Fundus photo. 45° field of view: 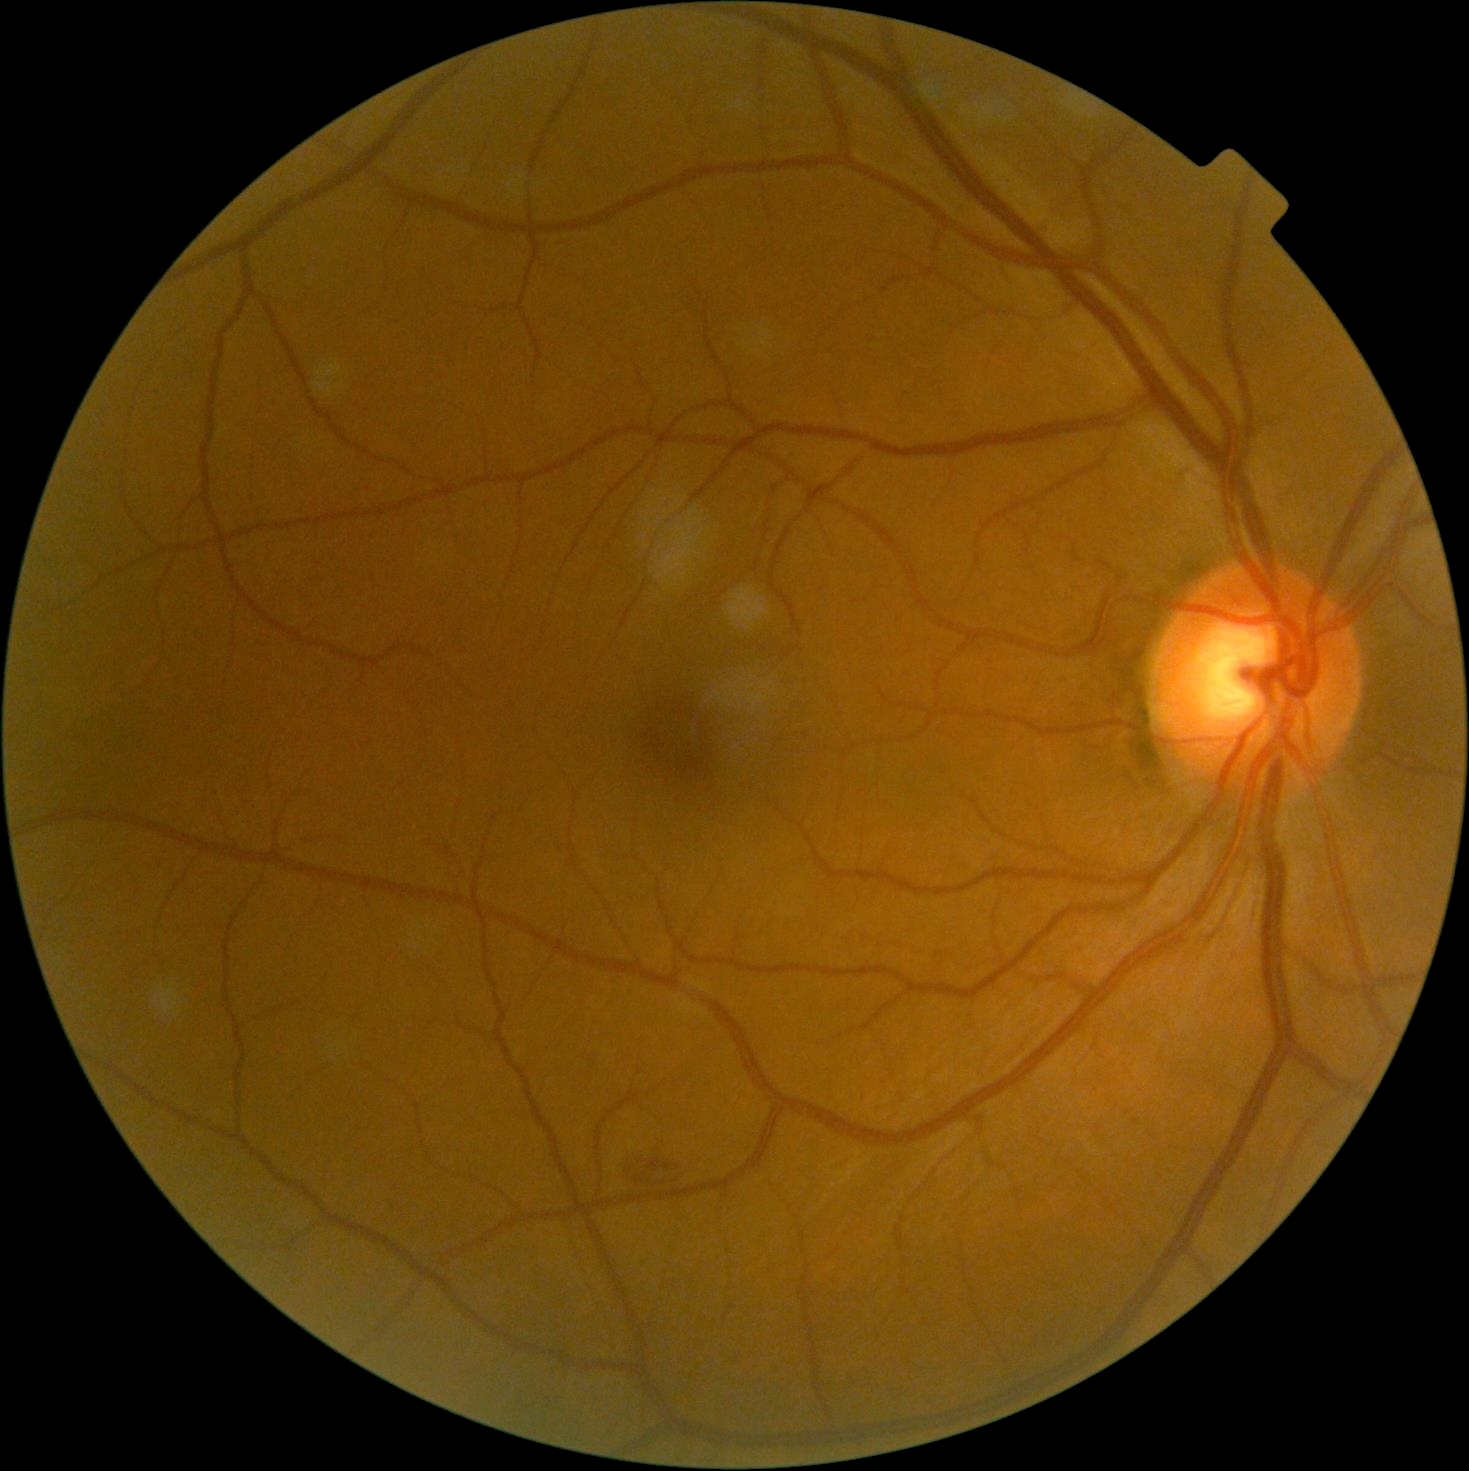
Diabetic retinopathy (DR) is 2/4.